Color fundus image · 45° field of view · 2352x1568px:
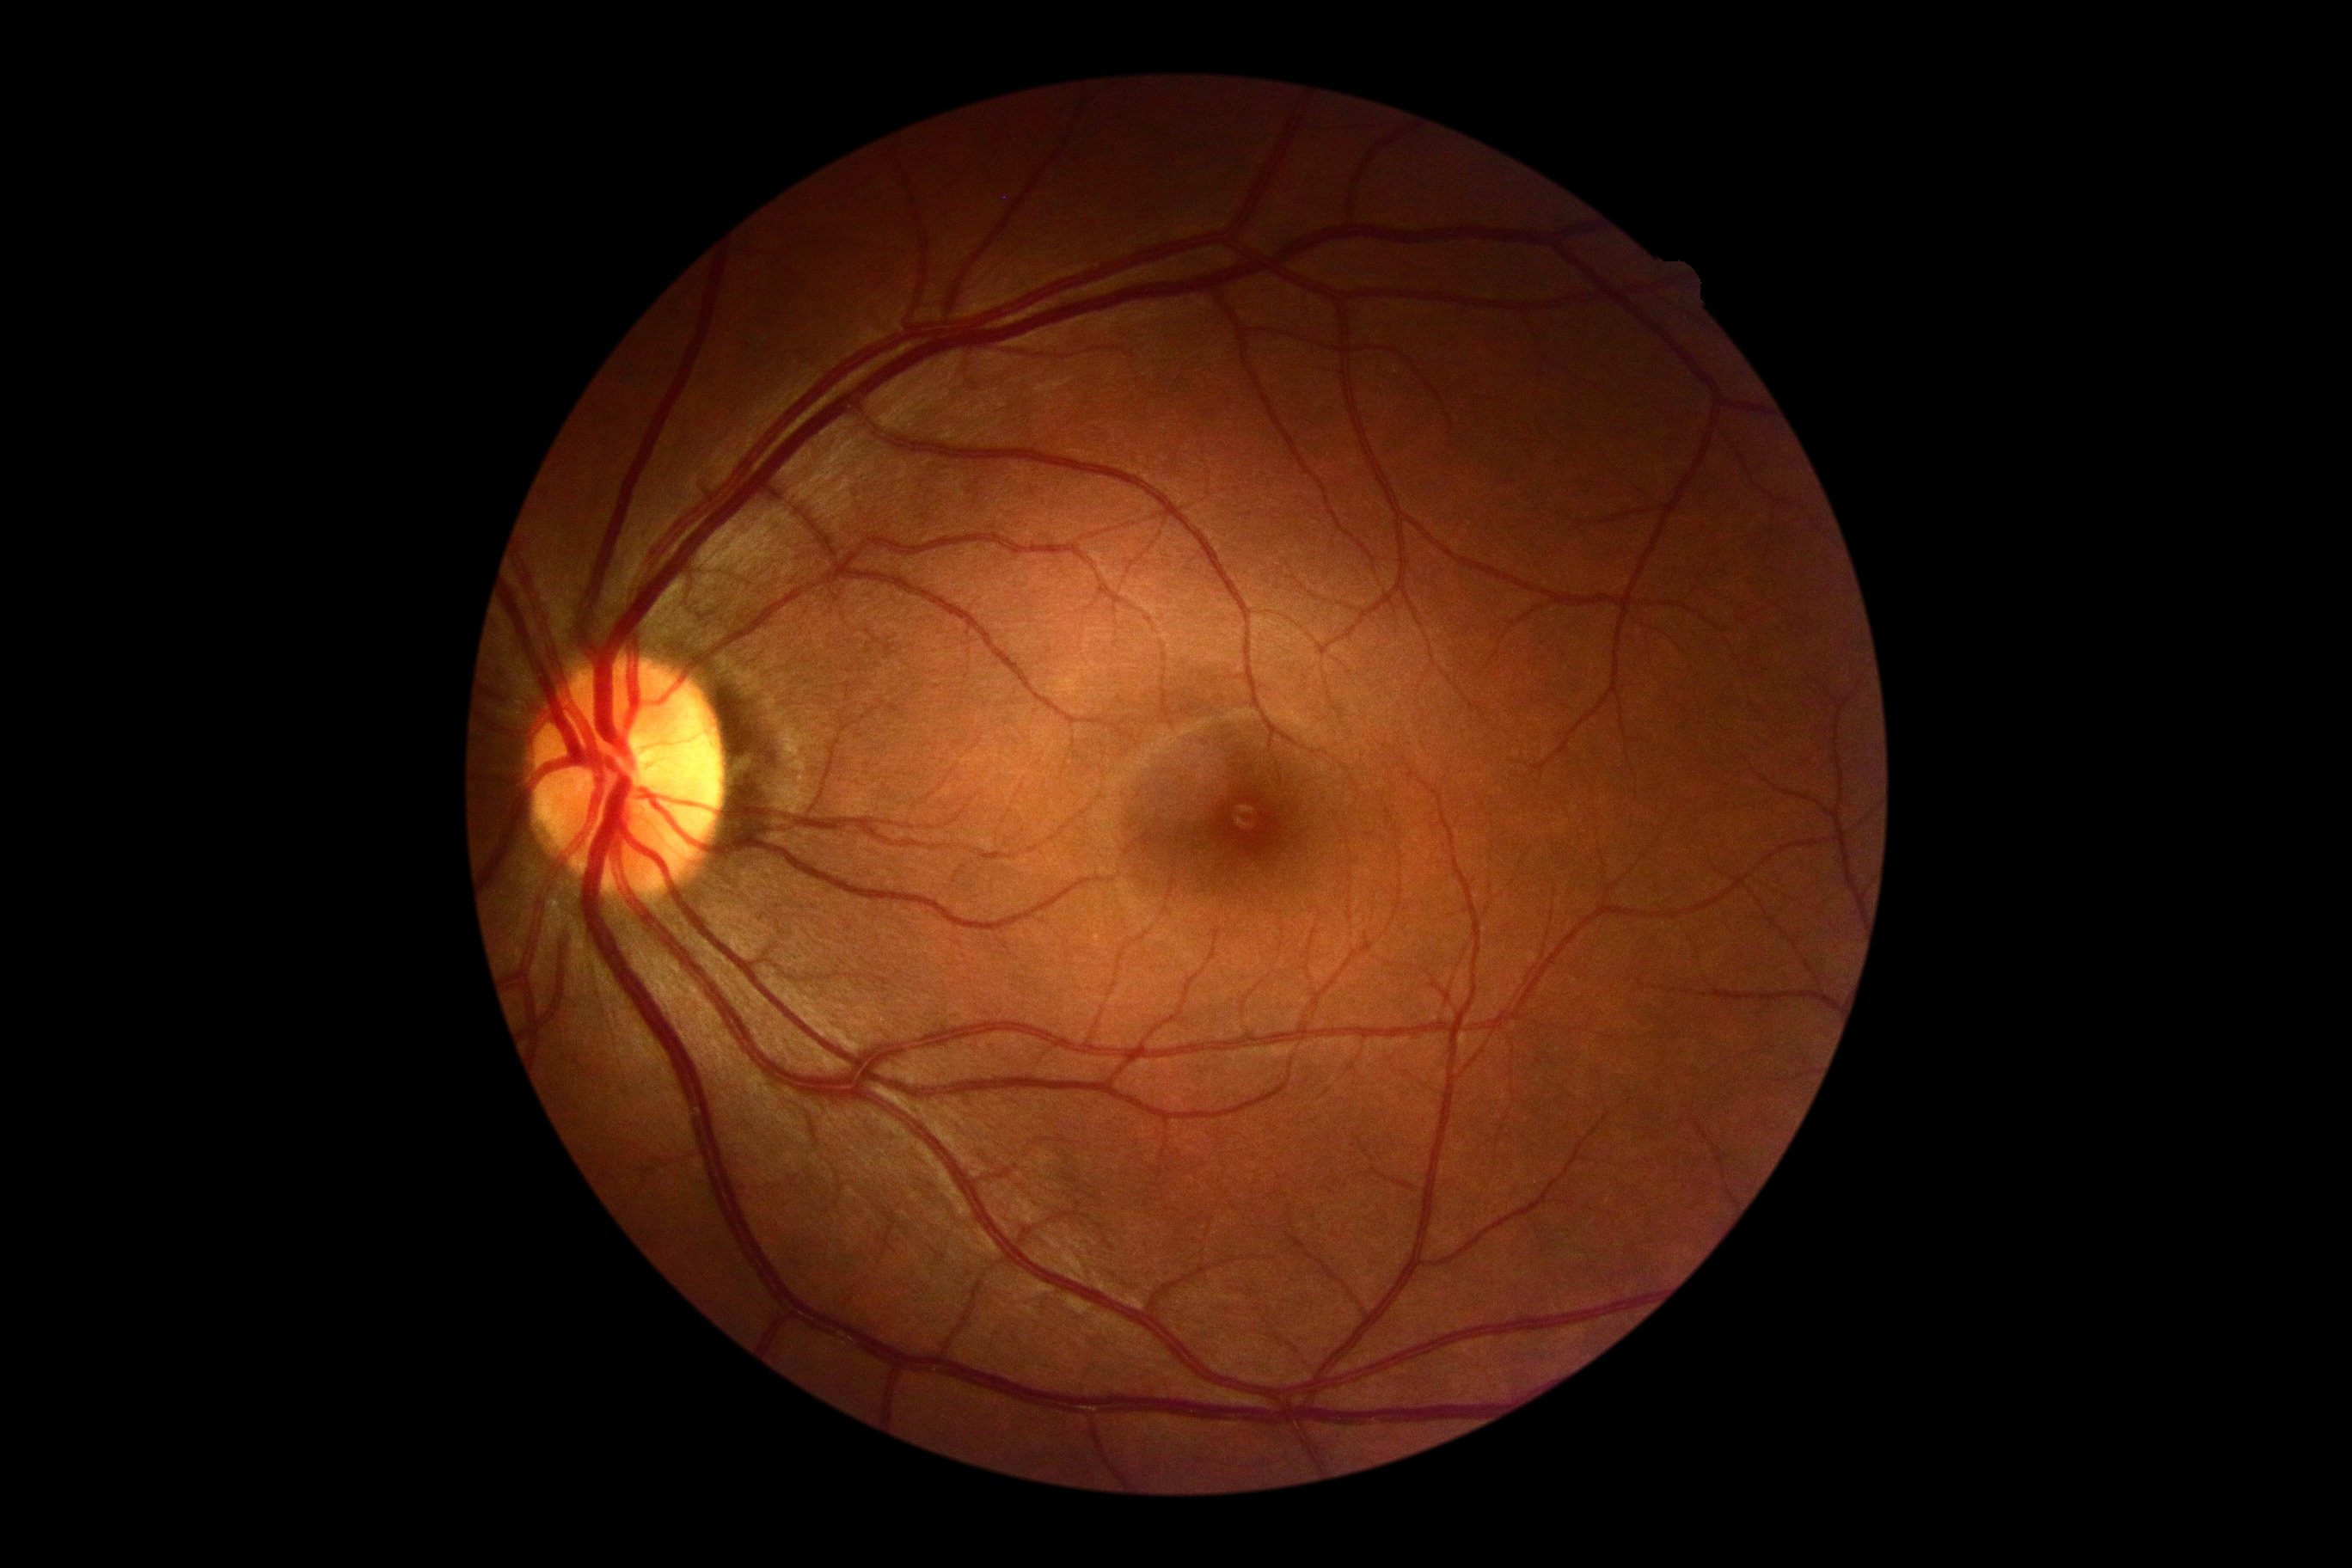 {
  "dr_grade": "0 (no apparent retinopathy)"
}